Wide-field contact fundus photograph of an infant; 100° field of view (Phoenix ICON); 1240 by 1240 pixels: 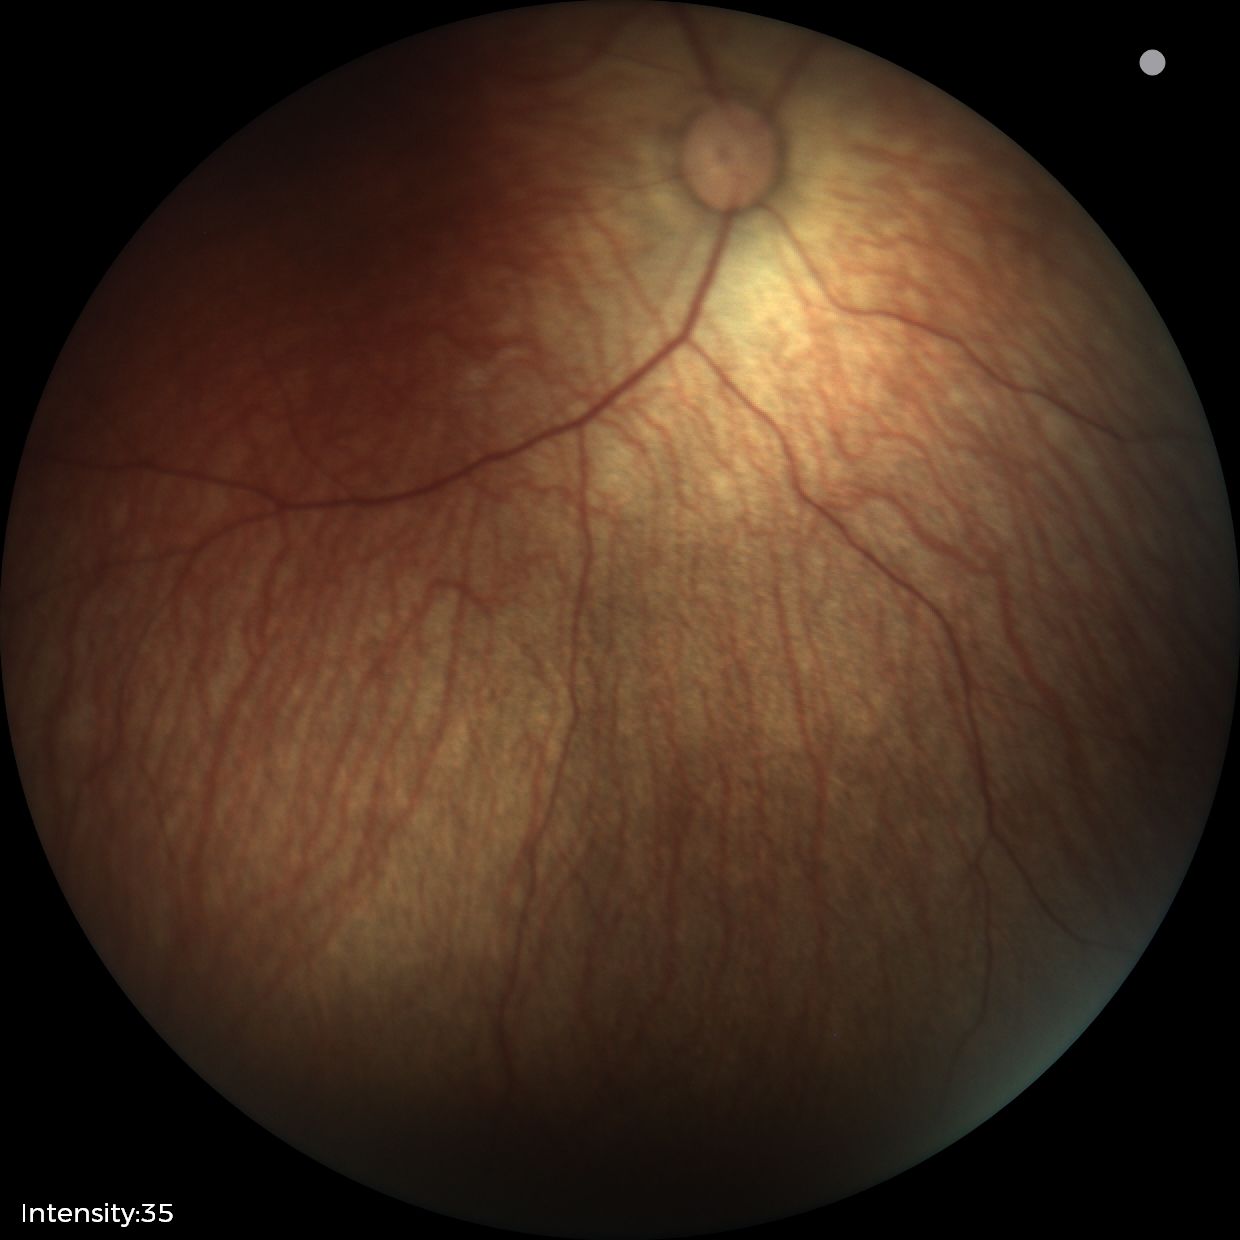
Examination with physiological retinal findings.